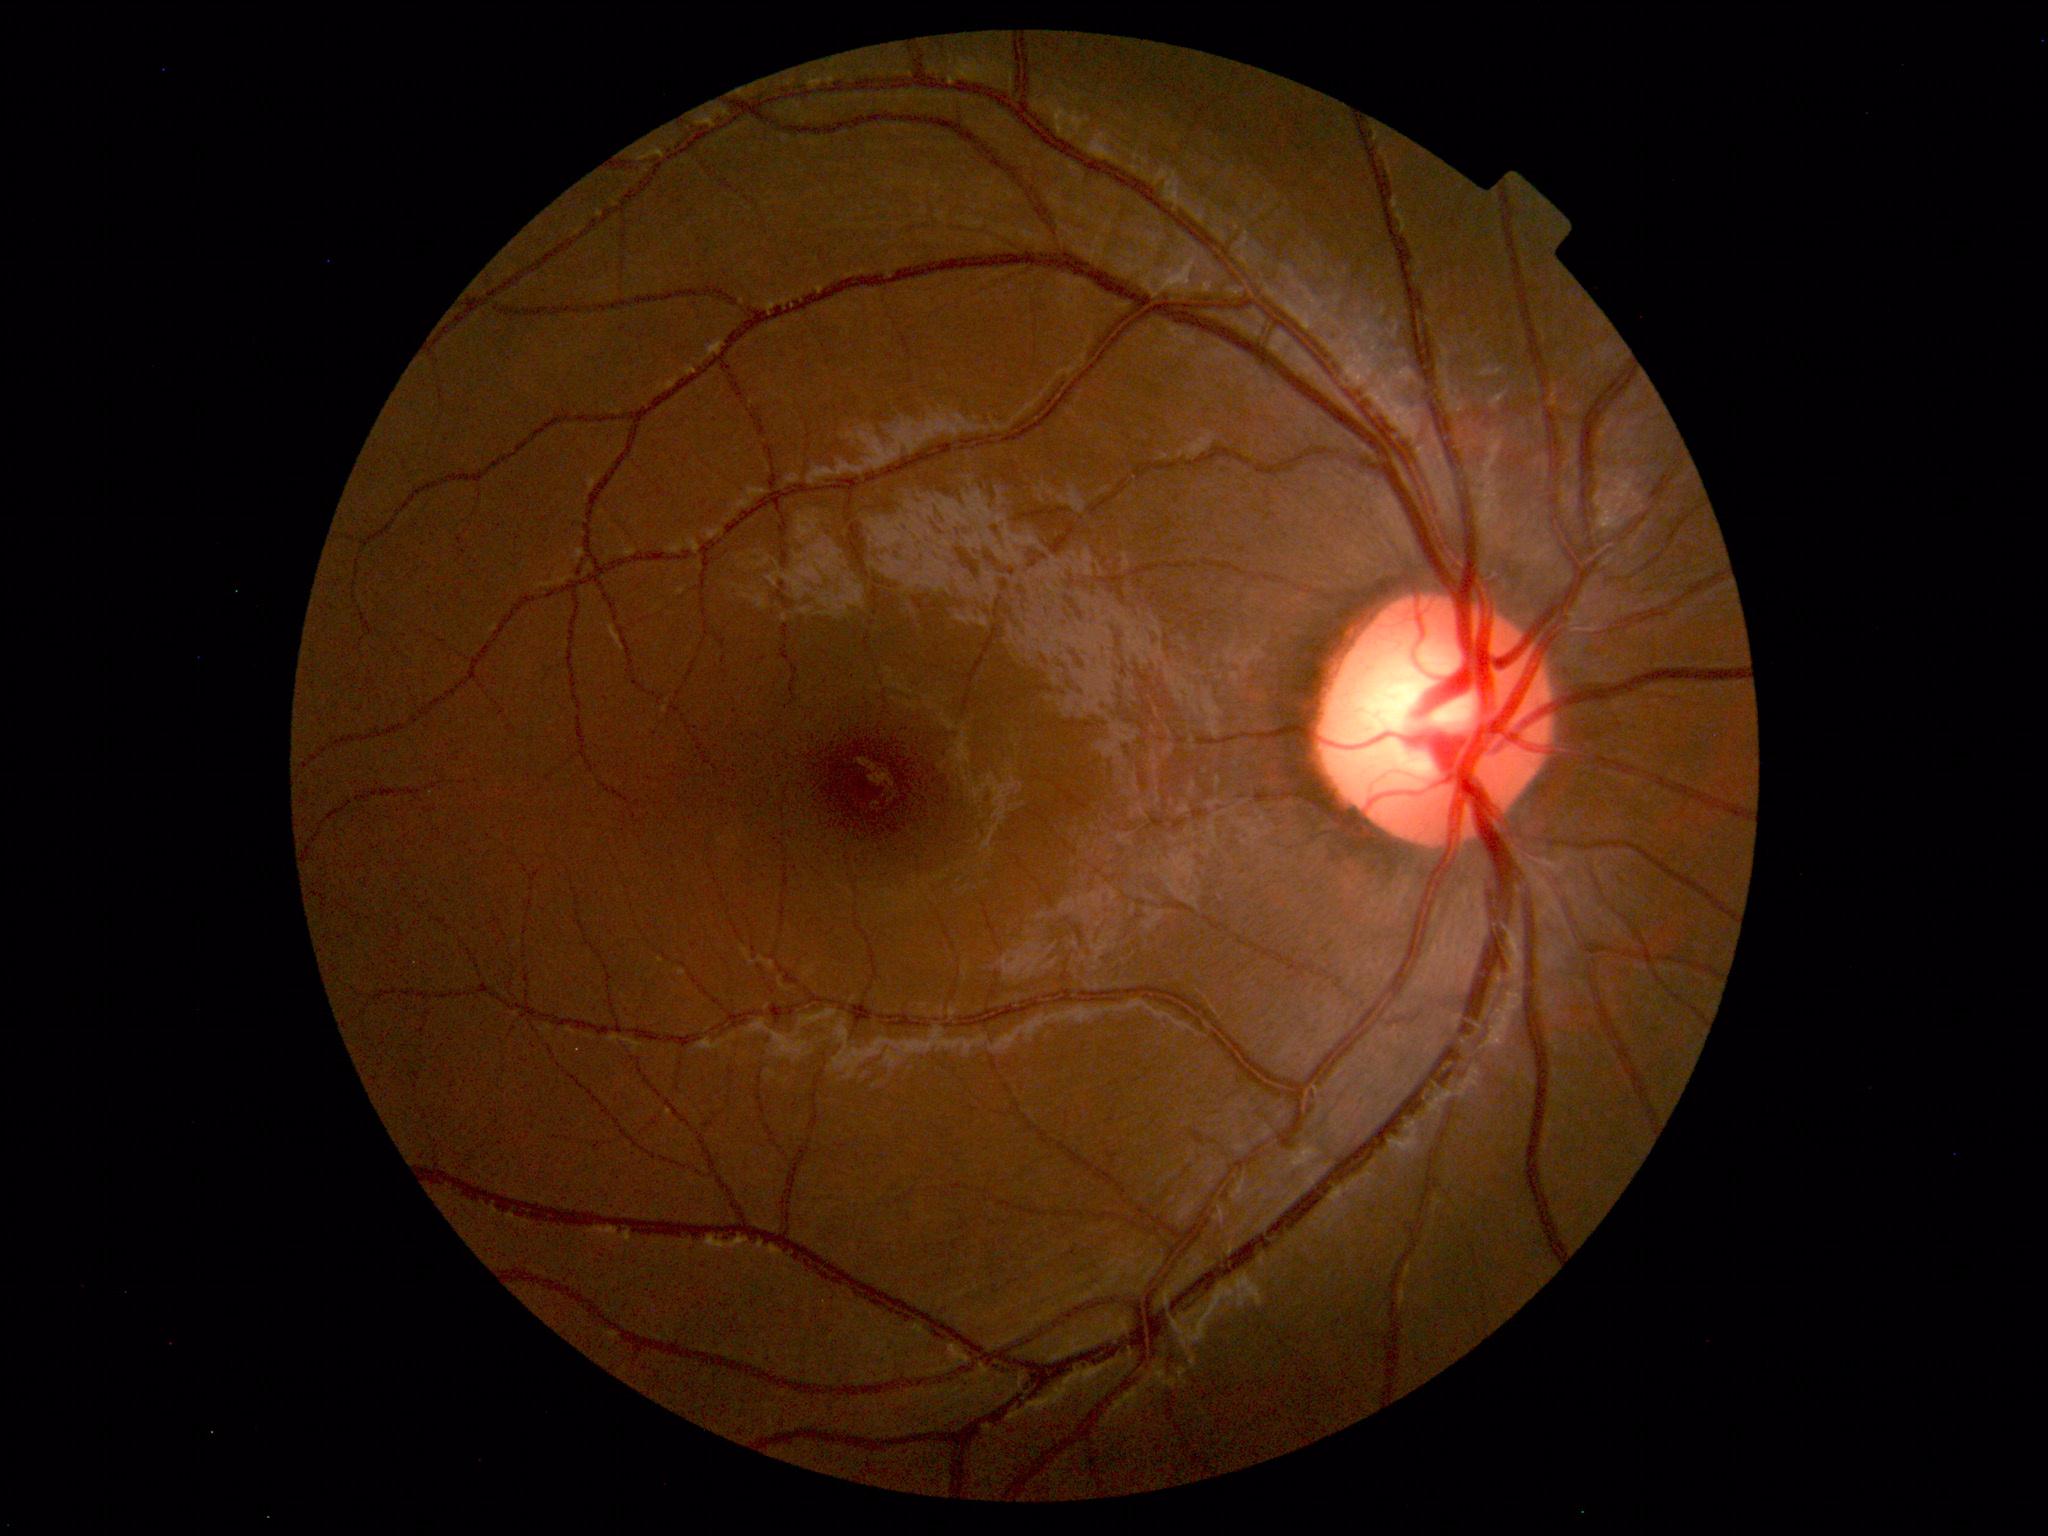

Impression: normal fundus.